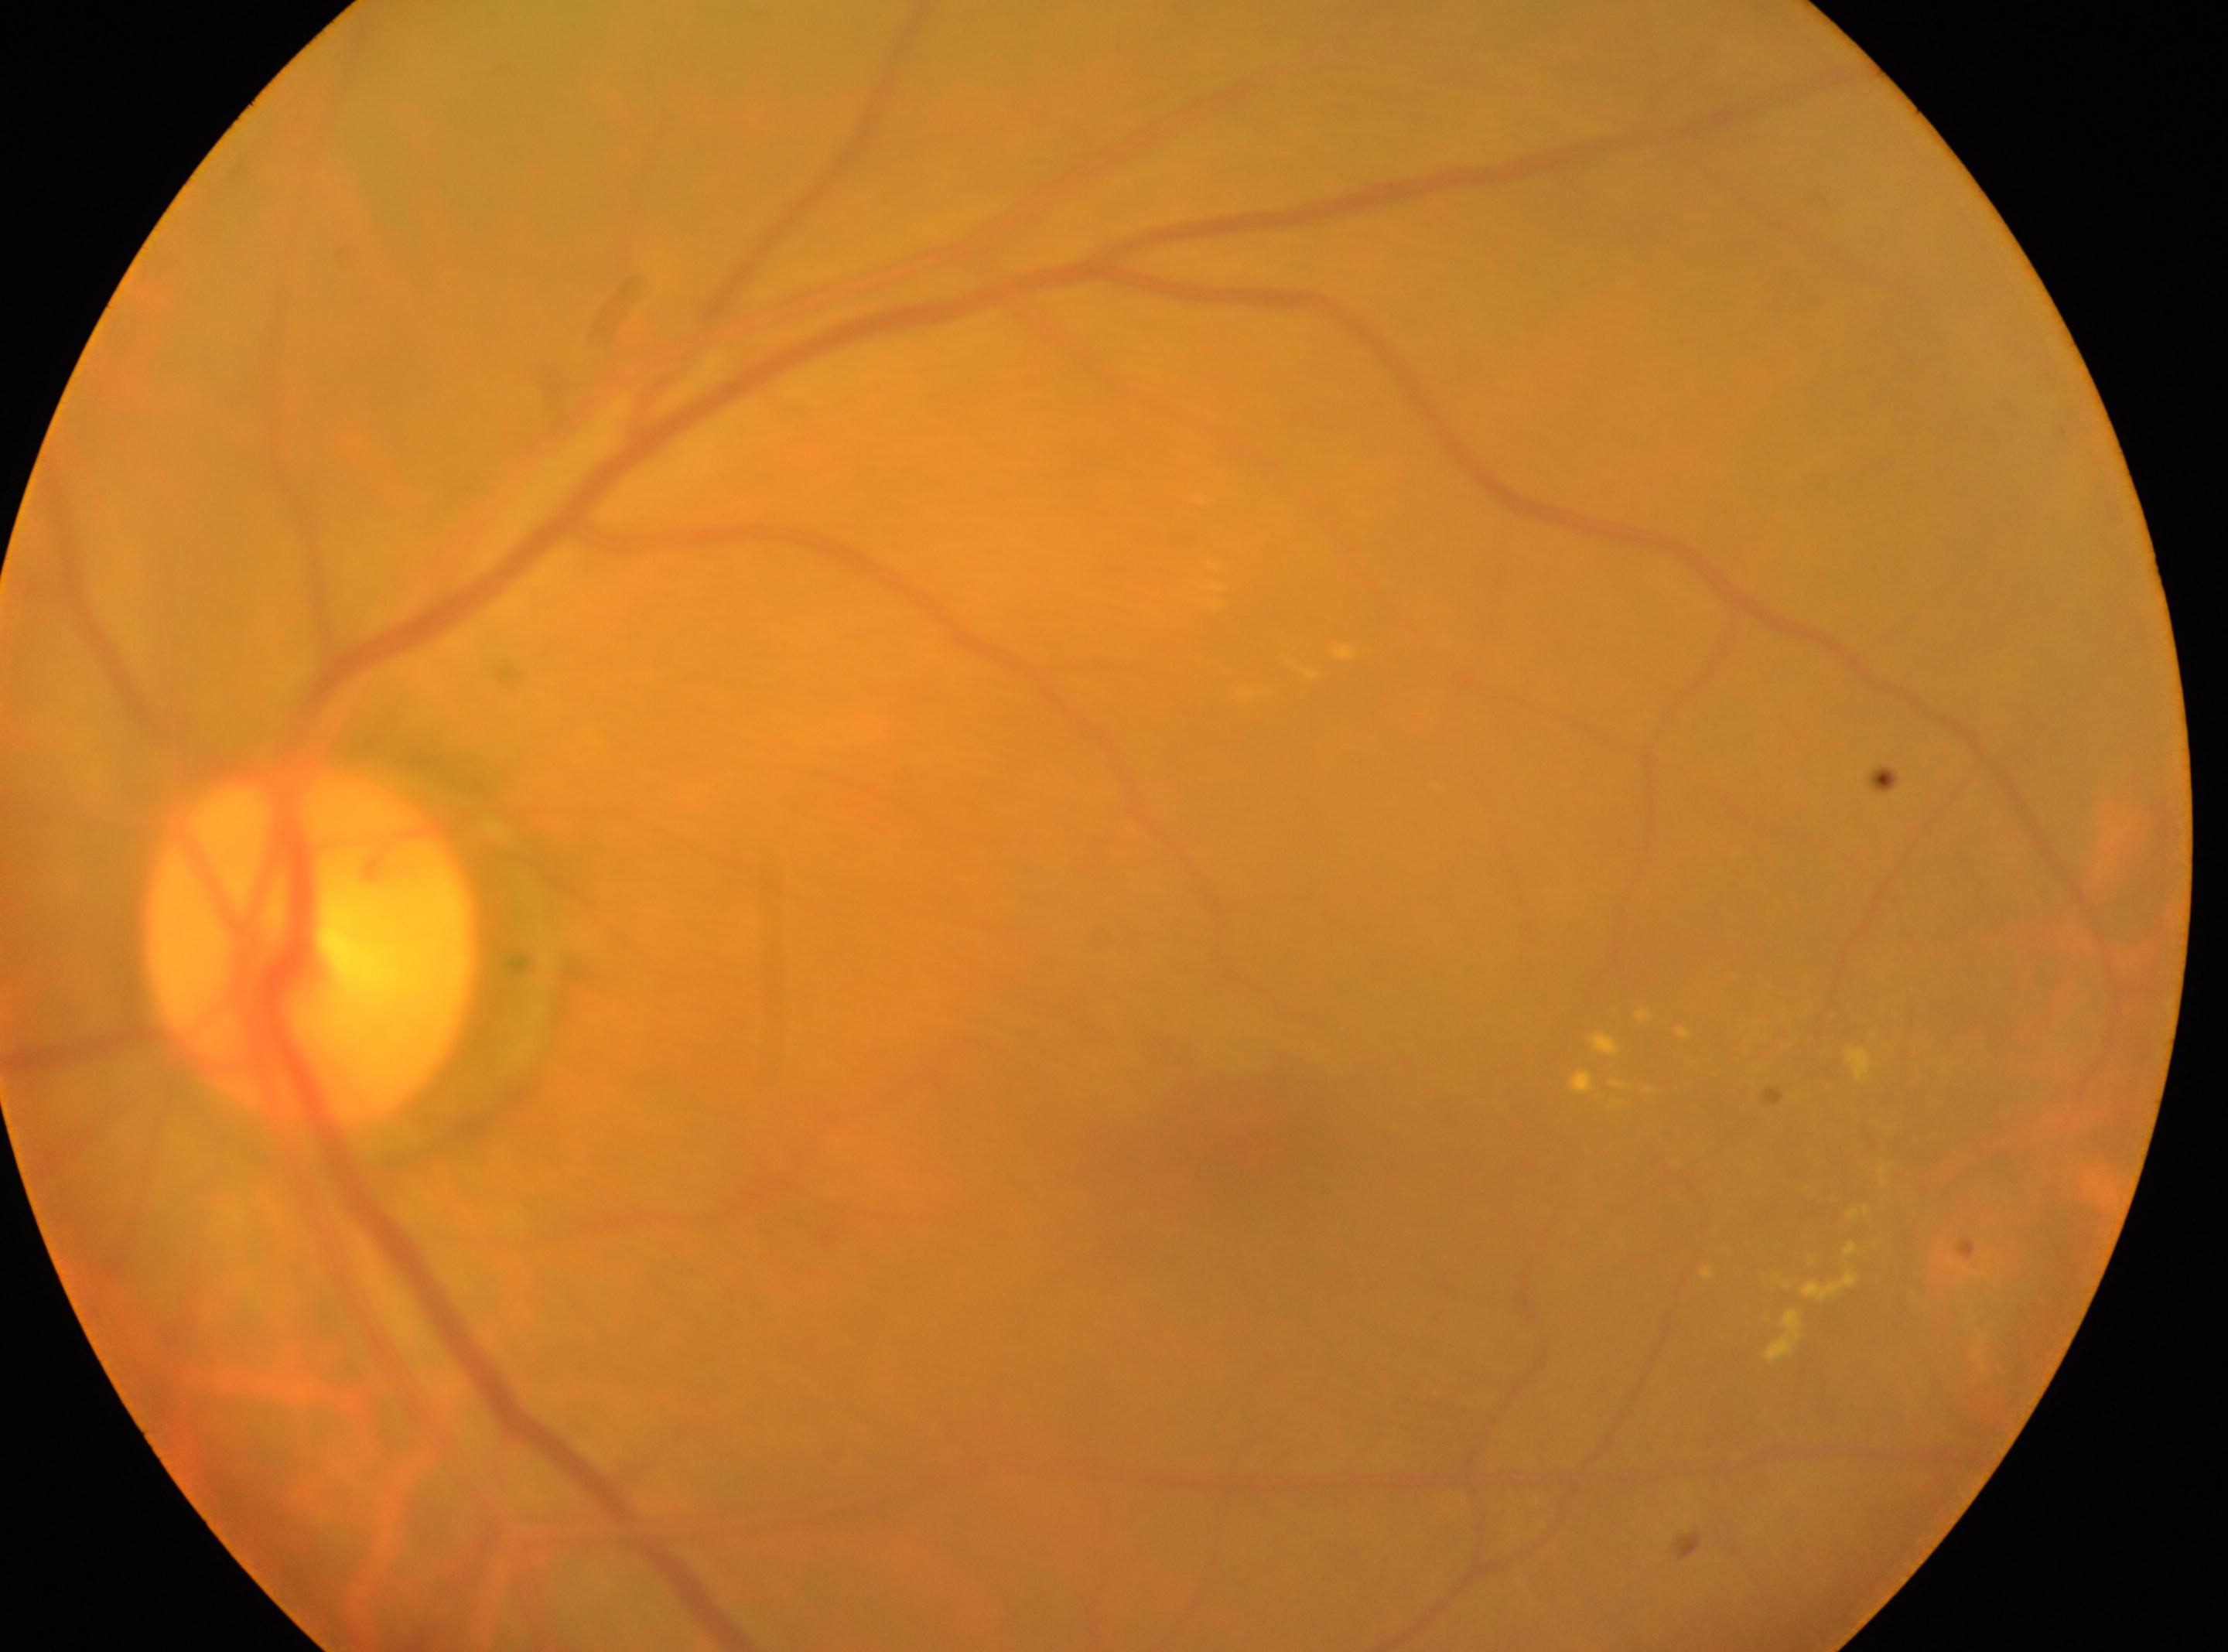 Fovea centralis located at 1253px, 1151px. DR severity is moderate non-proliferative diabetic retinopathy (grade 2). Imaged eye: left eye. The optic disc is at 308px, 947px.